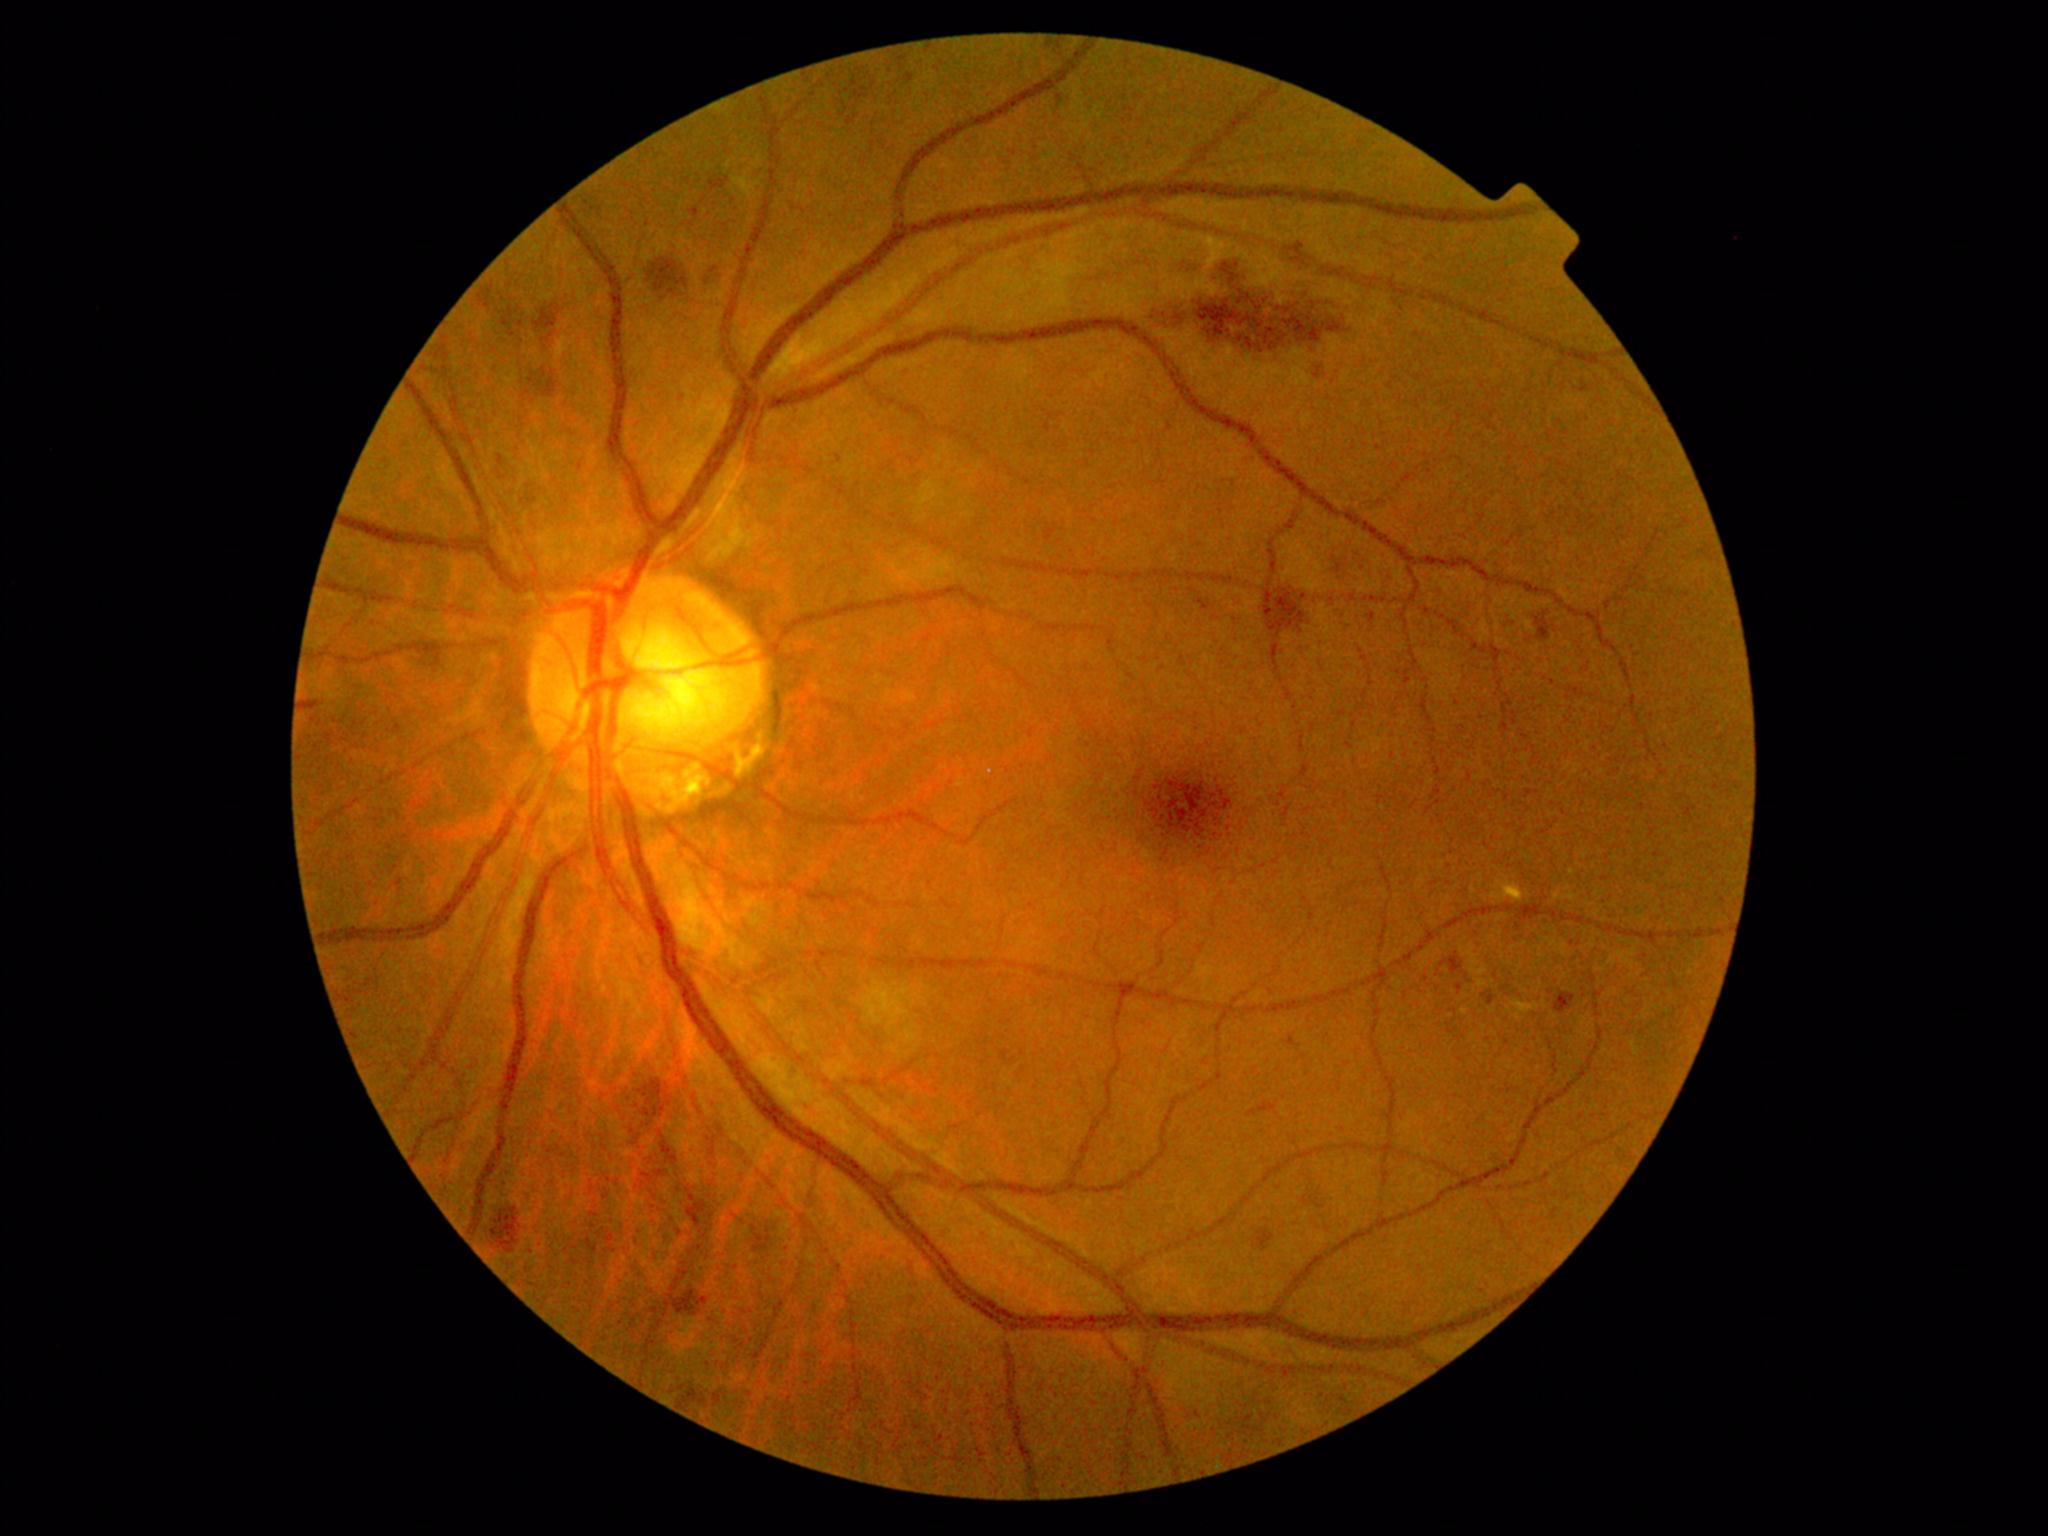 partial: true
dr_grade: 2
lesions:
  he:
    - region(837, 73, 870, 123)
    - region(705, 271, 727, 286)
    - region(1307, 1194, 1325, 1203)
    - region(759, 1223, 774, 1250)
    - region(1340, 561, 1354, 576)
    - region(514, 478, 539, 500)
    - region(539, 305, 562, 334)
    - region(1152, 265, 1352, 351)
    - region(679, 1390, 716, 1411)
    - region(662, 1303, 669, 1312)
    - region(1555, 994, 1576, 1014)
    - region(891, 53, 911, 83)
    - region(1259, 1227, 1278, 1246)
    - region(492, 1207, 522, 1253)
    - region(652, 261, 685, 296)
    - region(648, 1168, 662, 1177)
    - region(1248, 1107, 1268, 1118)
  ma:
    - region(1582, 384, 1589, 392)
    - region(1290, 241, 1300, 251)
    - region(1457, 984, 1463, 994)
    - region(1002, 1051, 1009, 1061)
    - region(1370, 613, 1375, 623)
    - region(1290, 1037, 1297, 1047)
    - region(1483, 994, 1494, 1005)
    - region(1315, 368, 1321, 379)
    - region(1199, 599, 1209, 610)
    - region(691, 209, 699, 218)
  ma_small_approx:
    - (x=1059, y=99)
    - (x=399, y=882)
  se:
    - region(863, 975, 926, 1034)
  ex:
    - region(1512, 999, 1540, 1021)
    - region(1461, 1009, 1469, 1015)
    - region(1492, 876, 1524, 904)
  ex_small_approx:
    - (x=1451, y=1016)